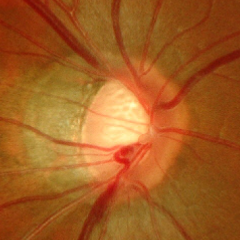

Q: Glaucoma assessment?
A: Advanced glaucomatous optic neuropathy. Defined as near-total cupping of the optic nerve head, with or without severe visual field loss within the central 10 degrees of fixation.